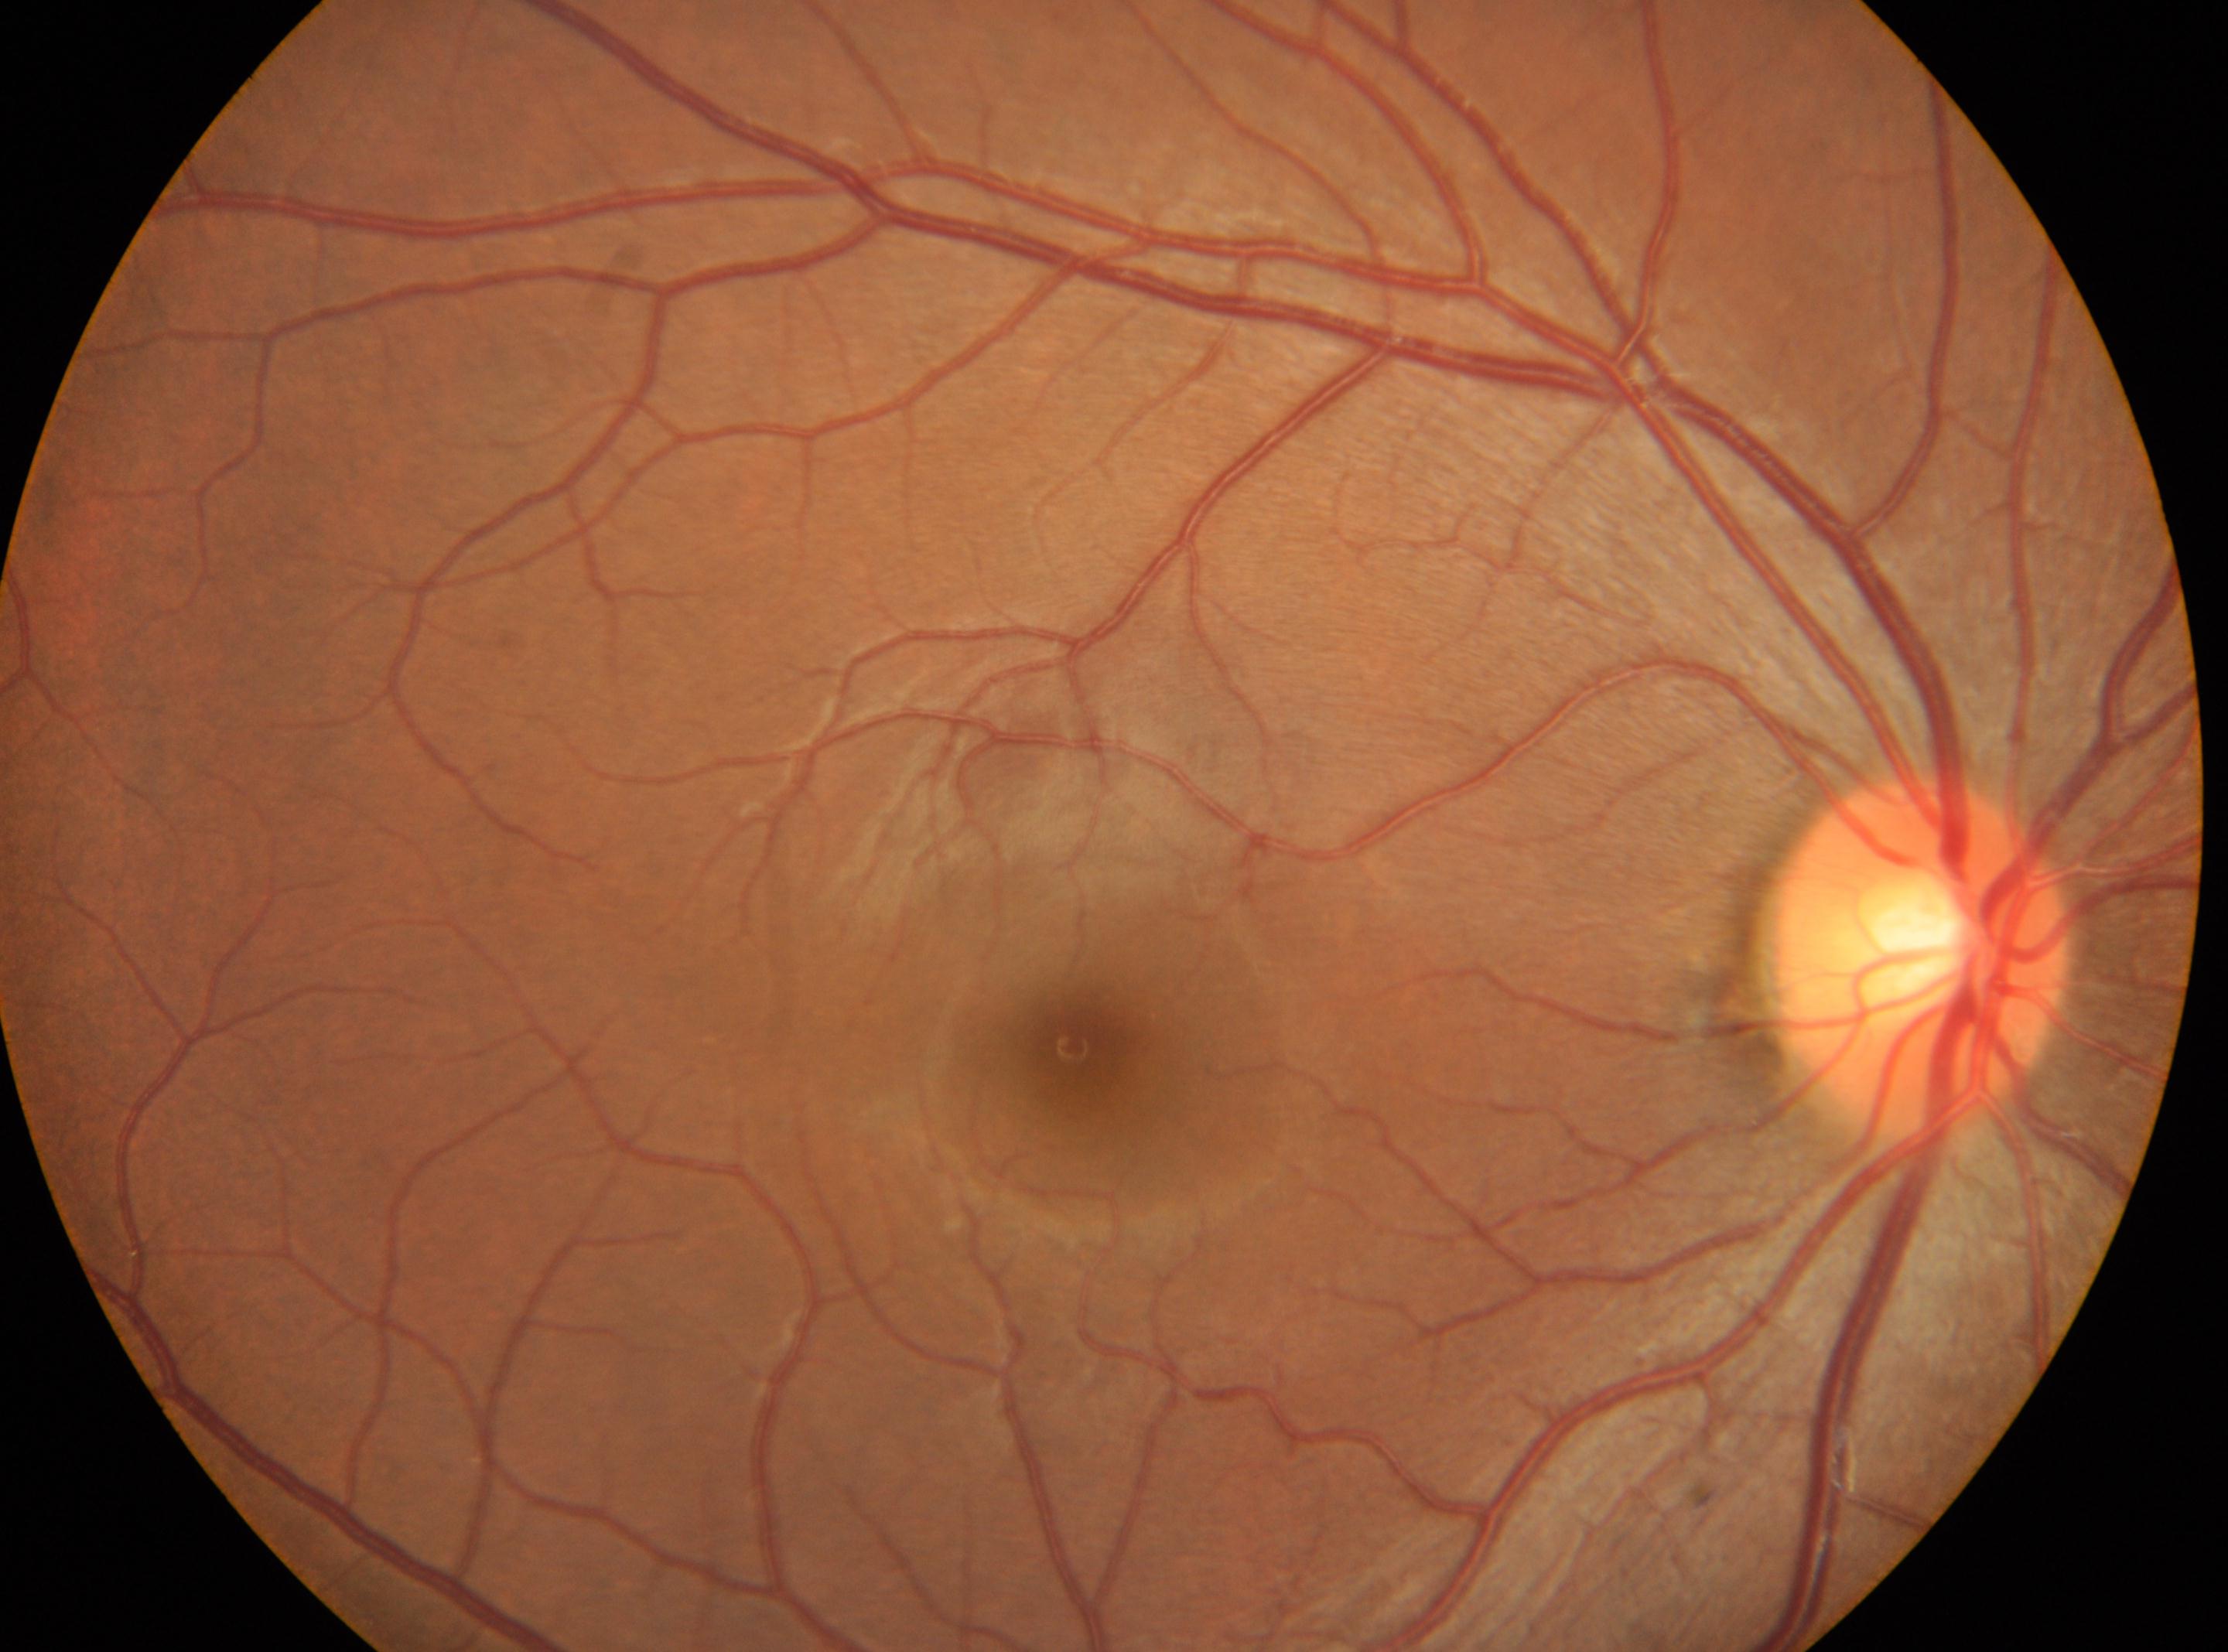

No DR findings. Foveal center located at 1072, 1049. Eye: right. Optic nerve head located at 1923, 954. DR severity: 0/4.